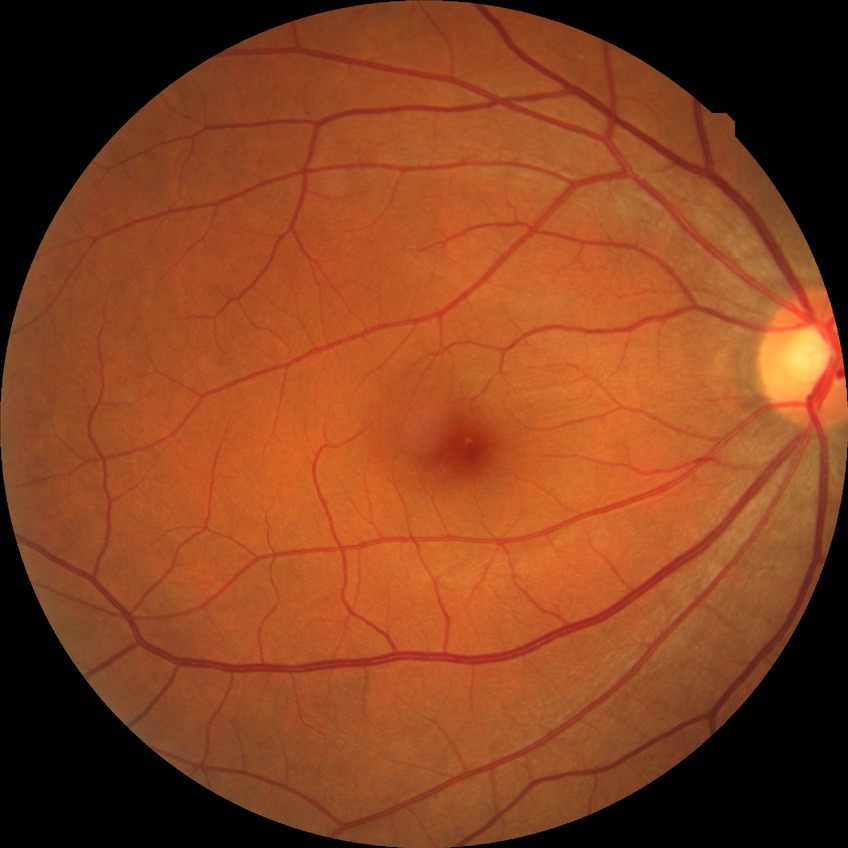
diabetic retinopathy (DR) = no diabetic retinopathy (NDR).